Pediatric wide-field fundus photograph:
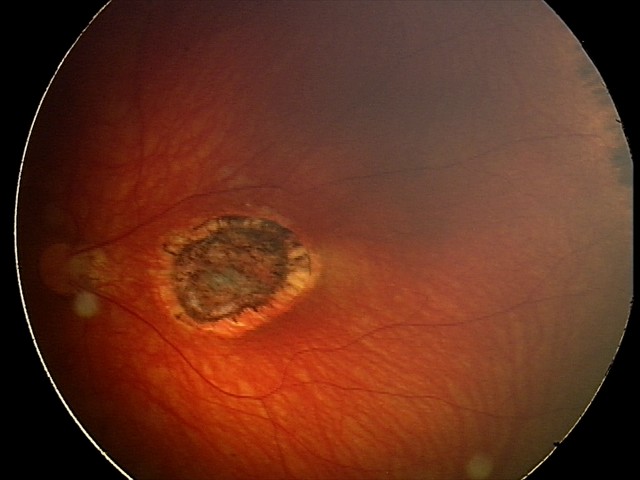 Impression: toxoplasmosis chorioretinitis.